Graded on the modified Davis scale: 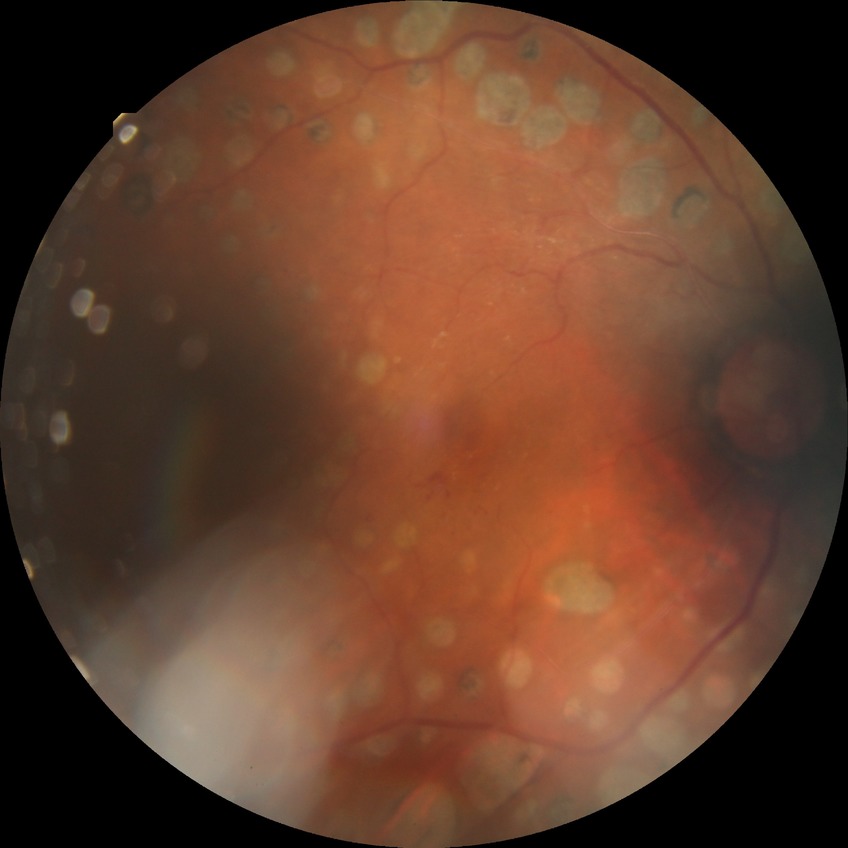
DR grade is PDR.